2352 by 1568 pixels — 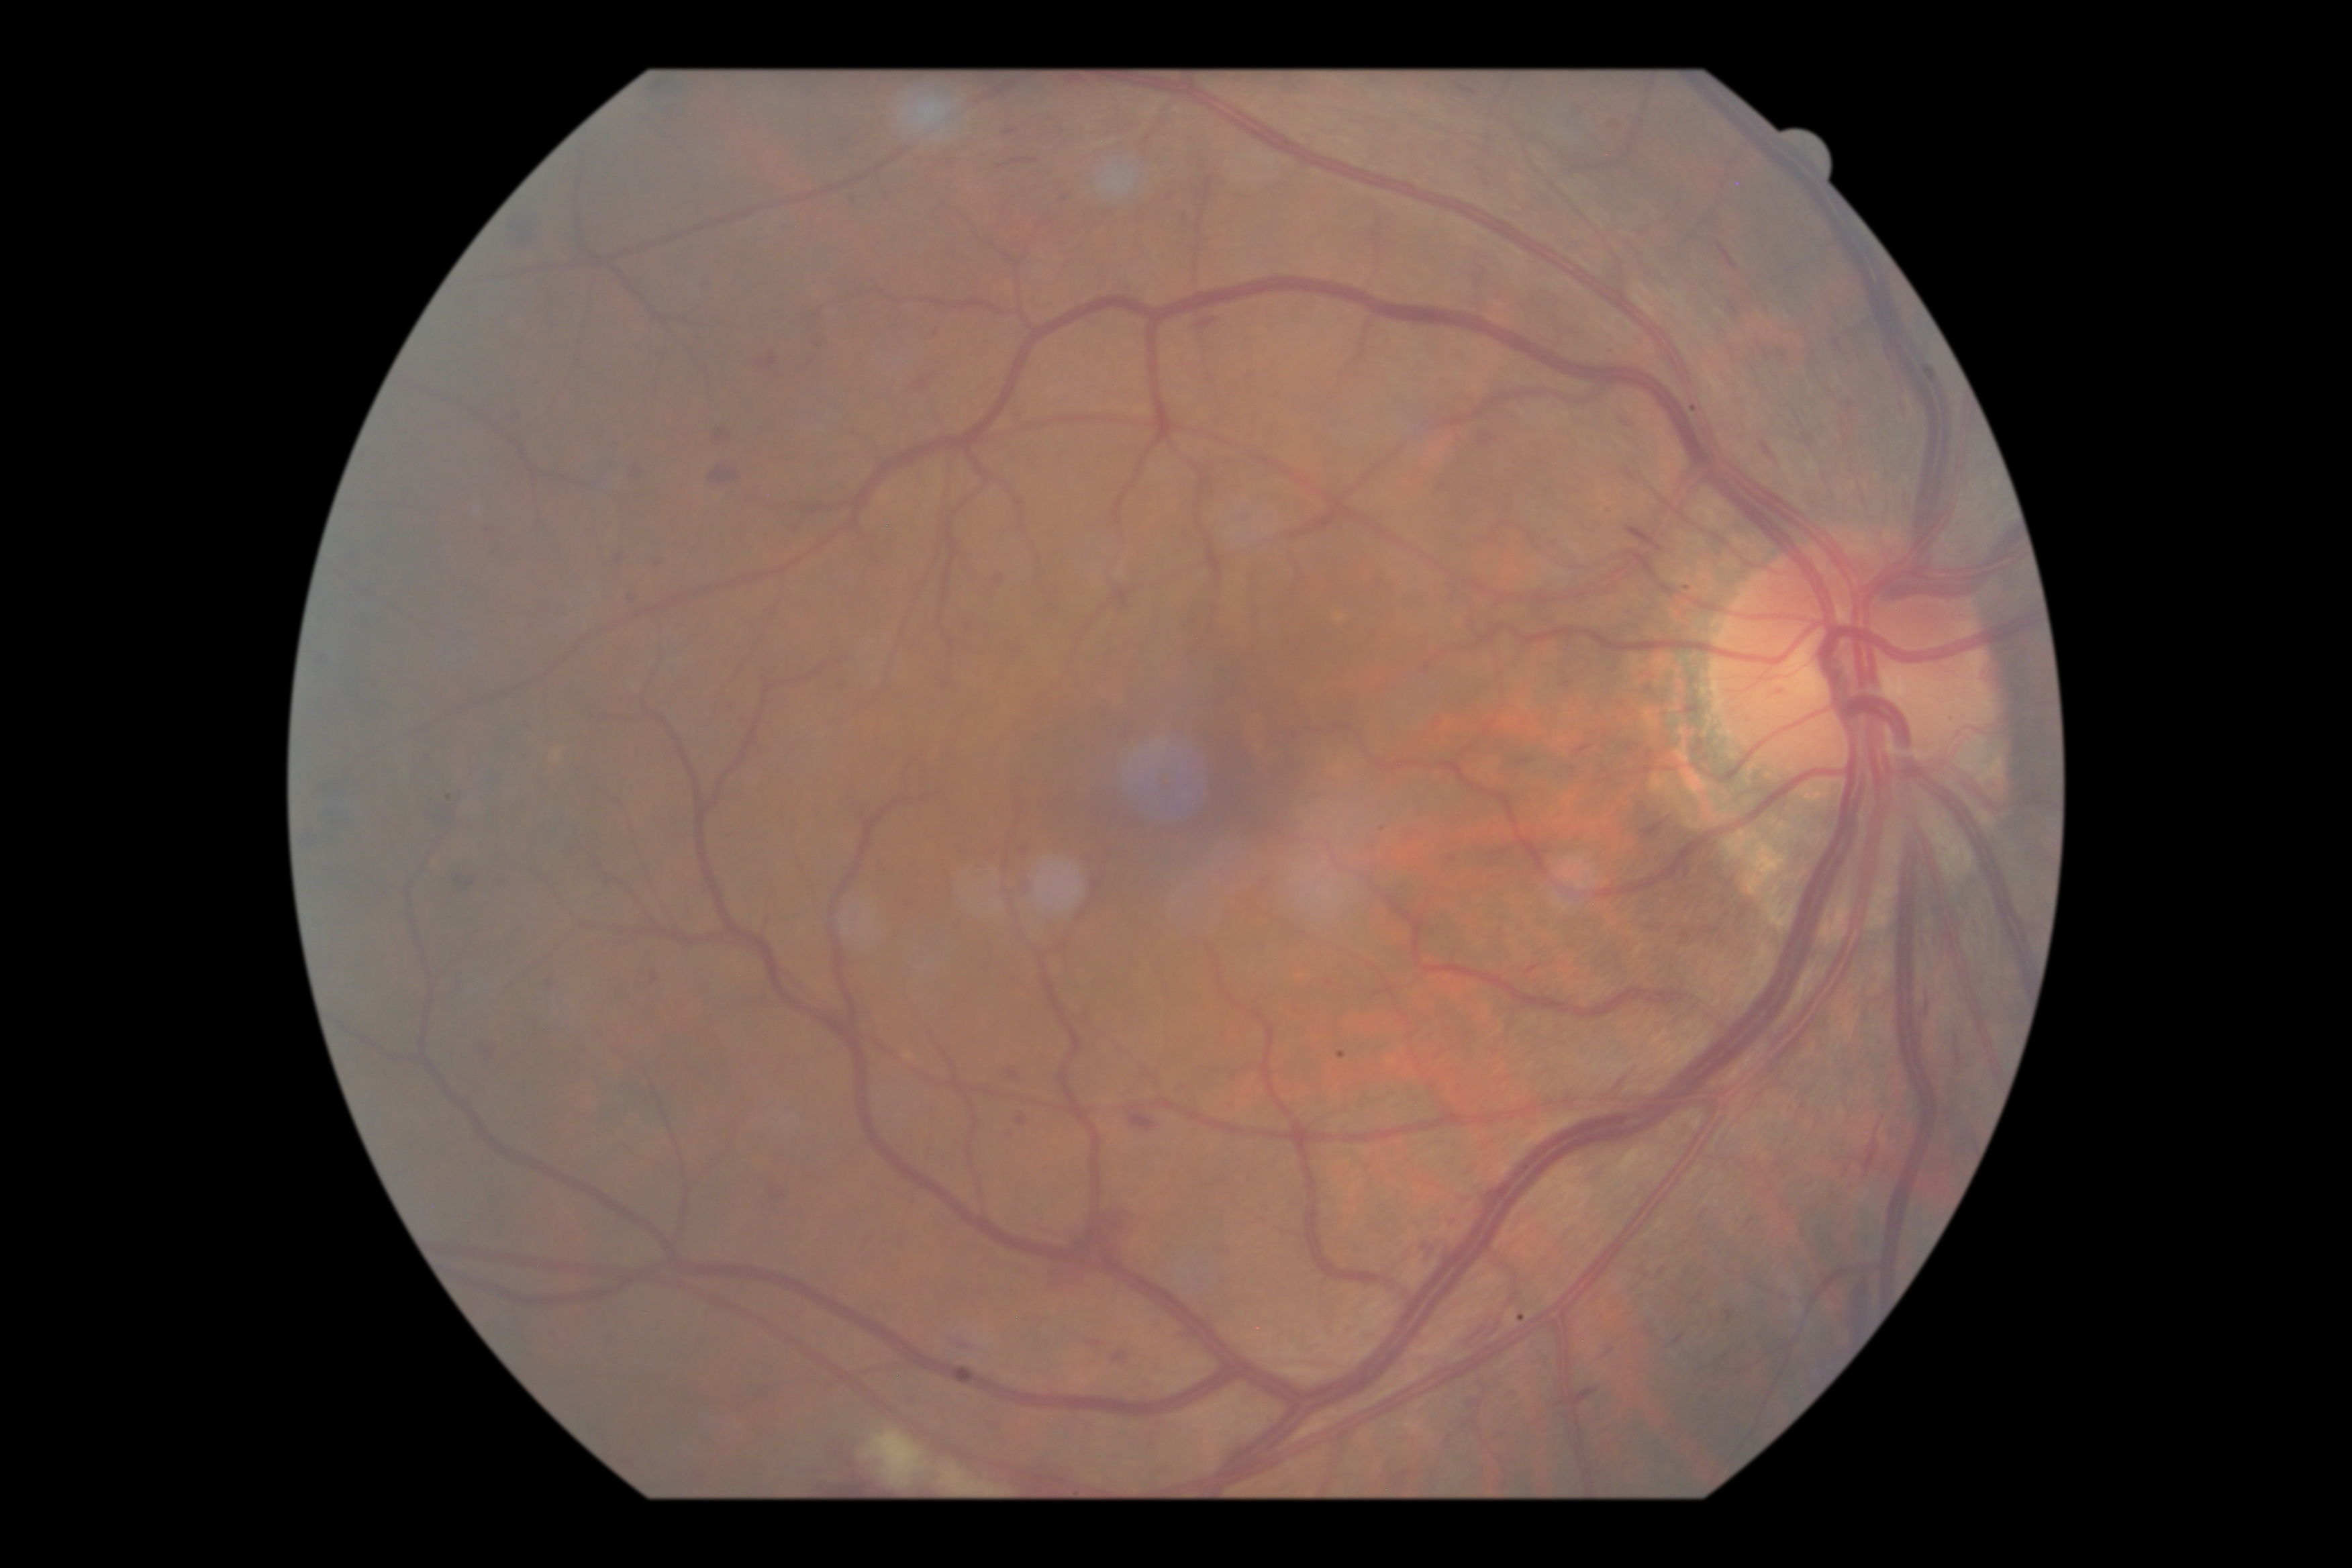 {
  "dr_grade": "2"
}